Camera: Nidek AFC-330; optic nerve head crop:
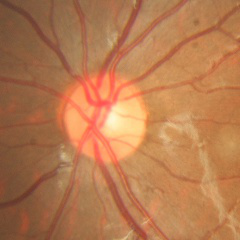
Color fundus photograph showing no glaucoma.